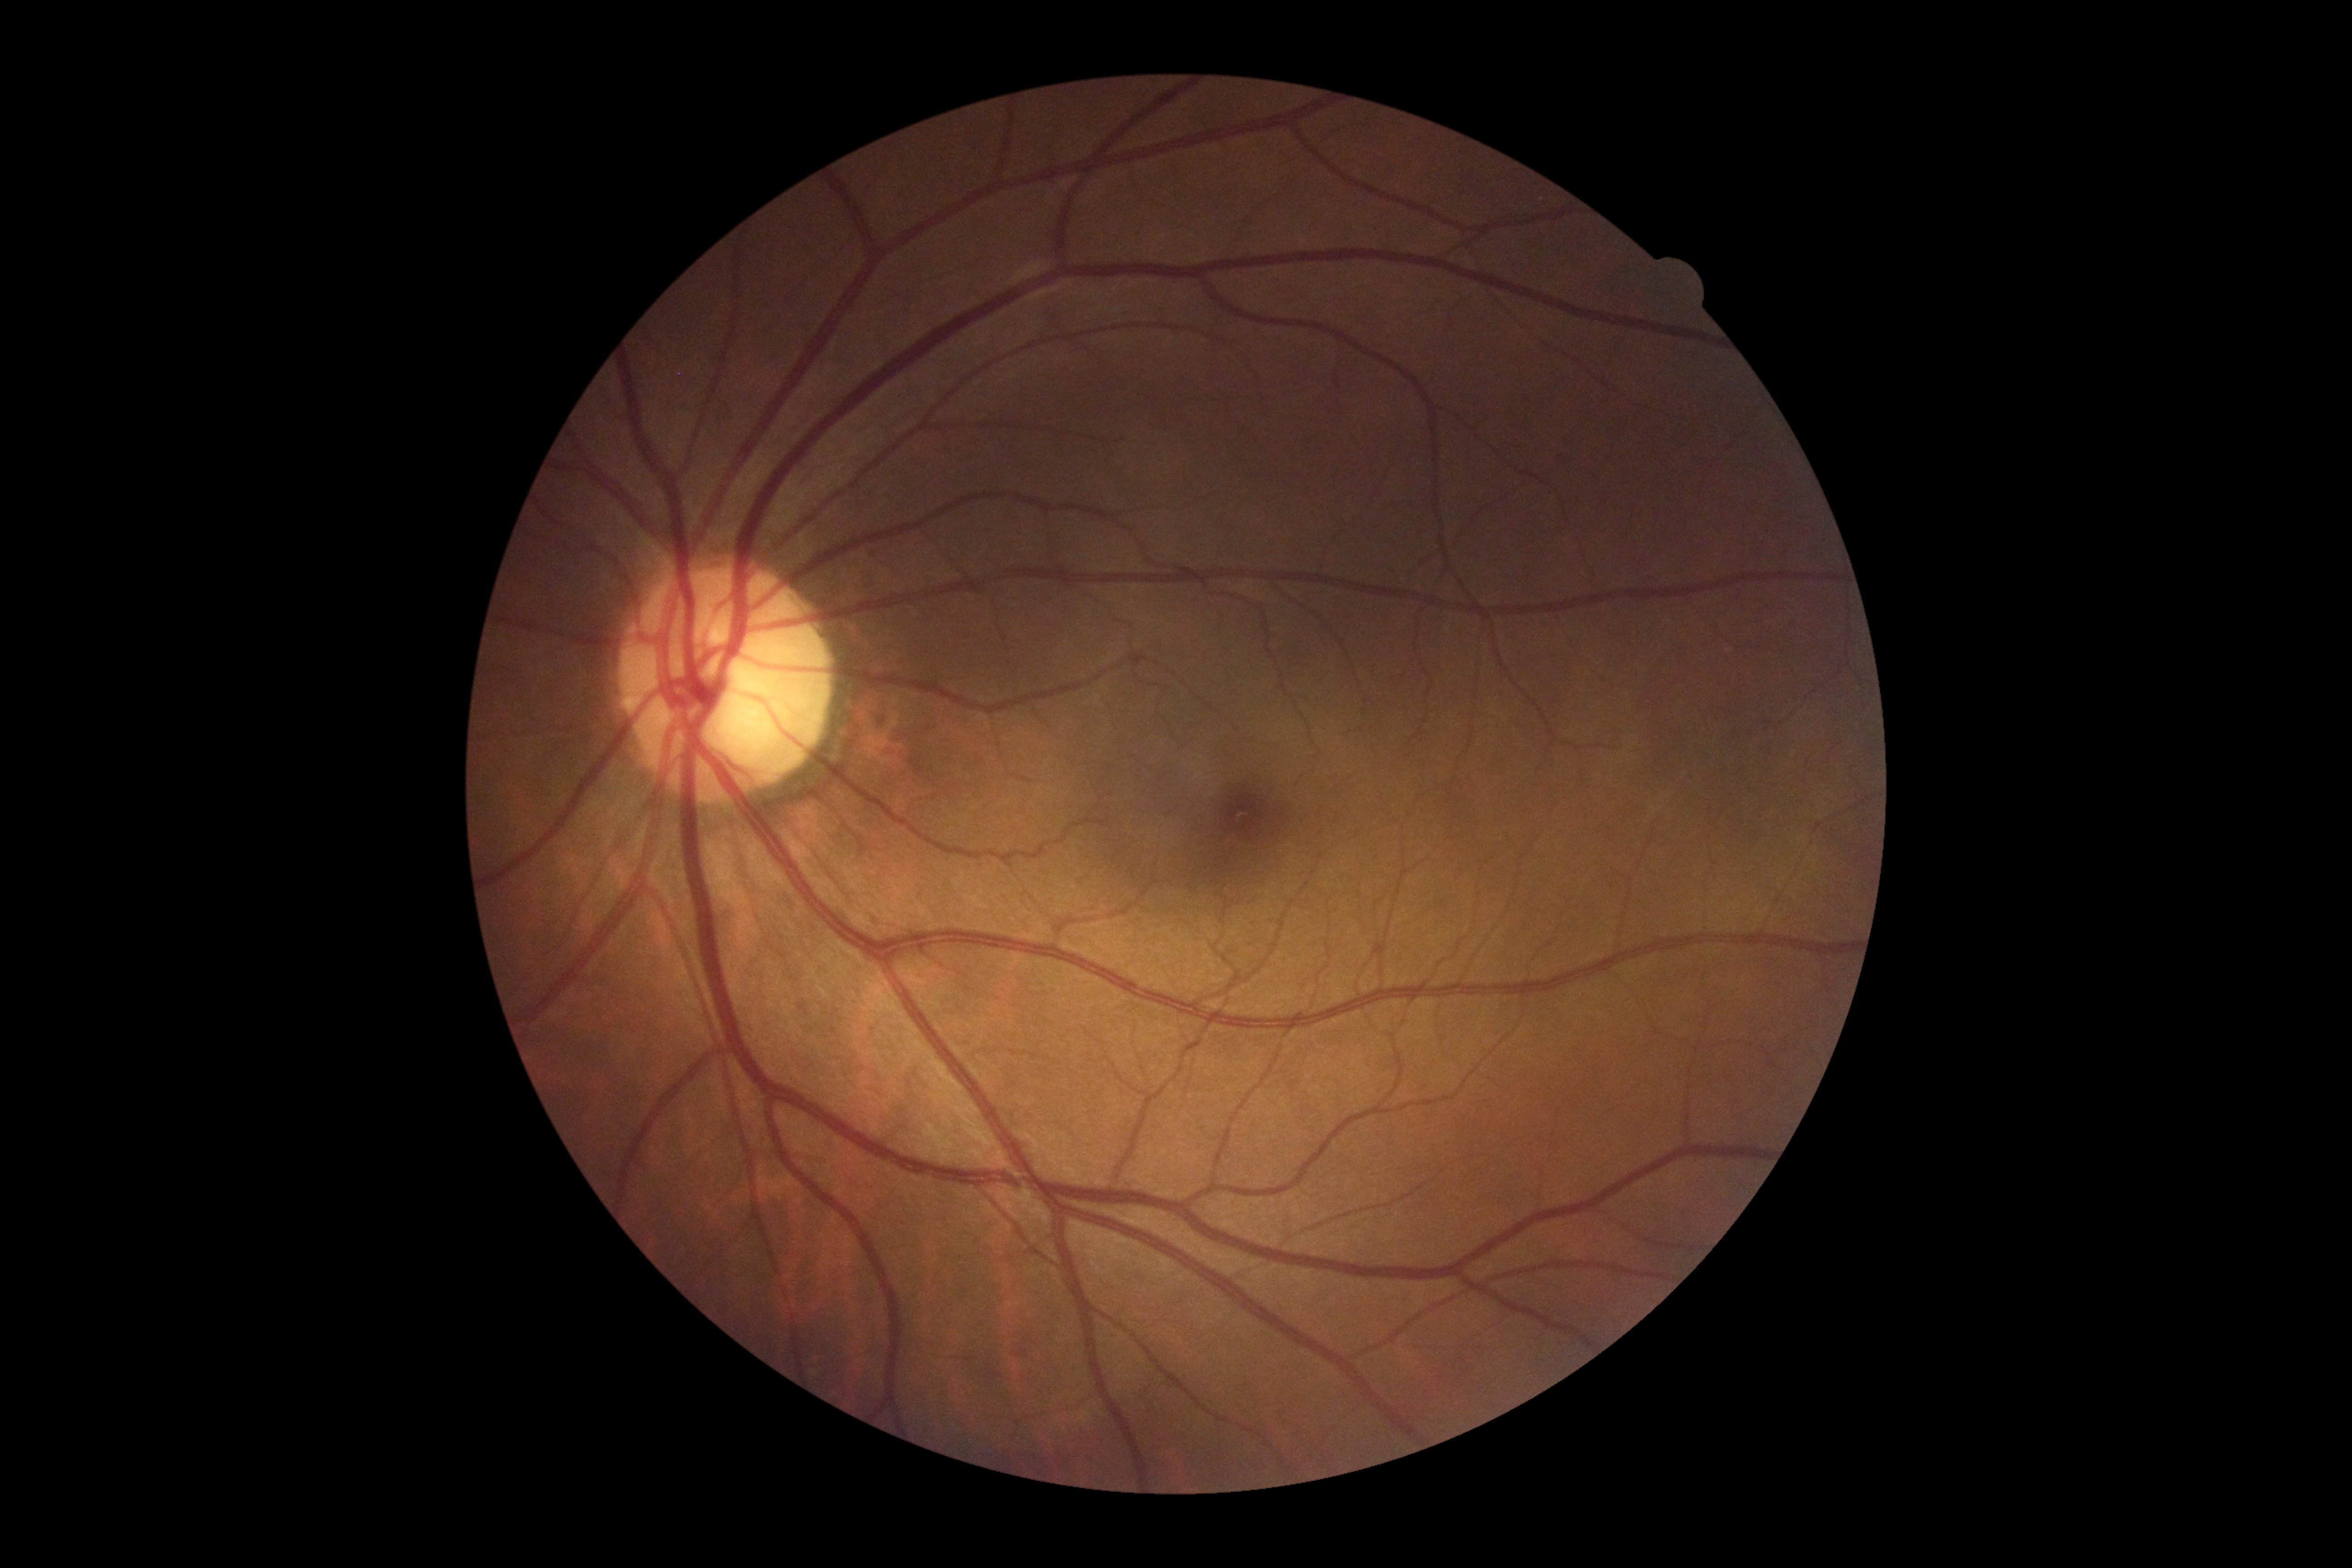

DR grade is no apparent retinopathy (0).